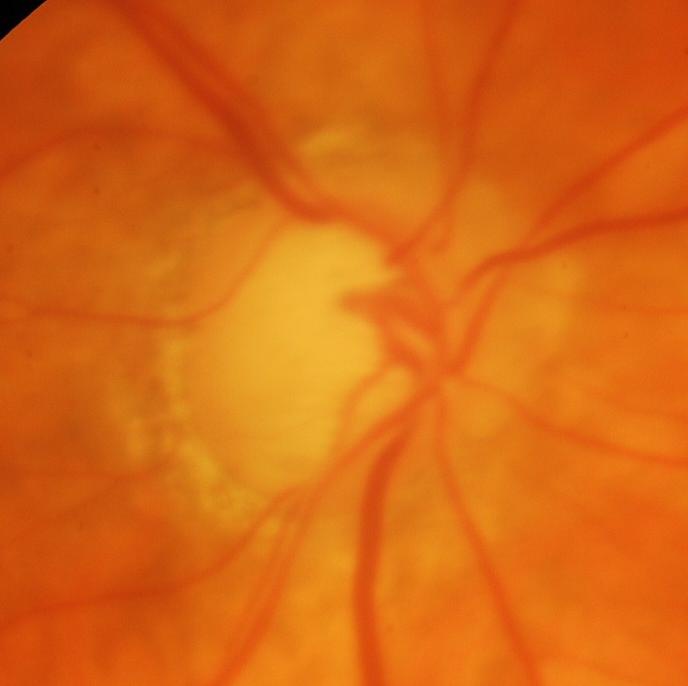 Glaucomatous optic neuropathy is present. Impression: glaucomatous findings.